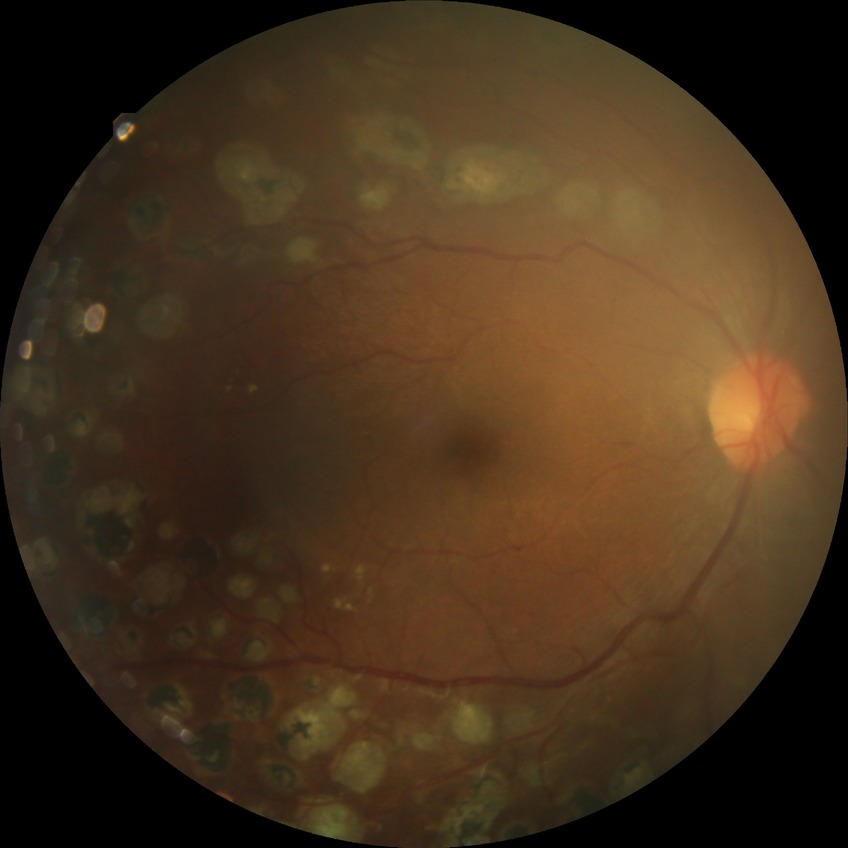

Diabetic retinopathy stage: proliferative diabetic retinopathy.